Wide-field fundus photograph of an infant. Natus RetCam Envision, 130° FOV: 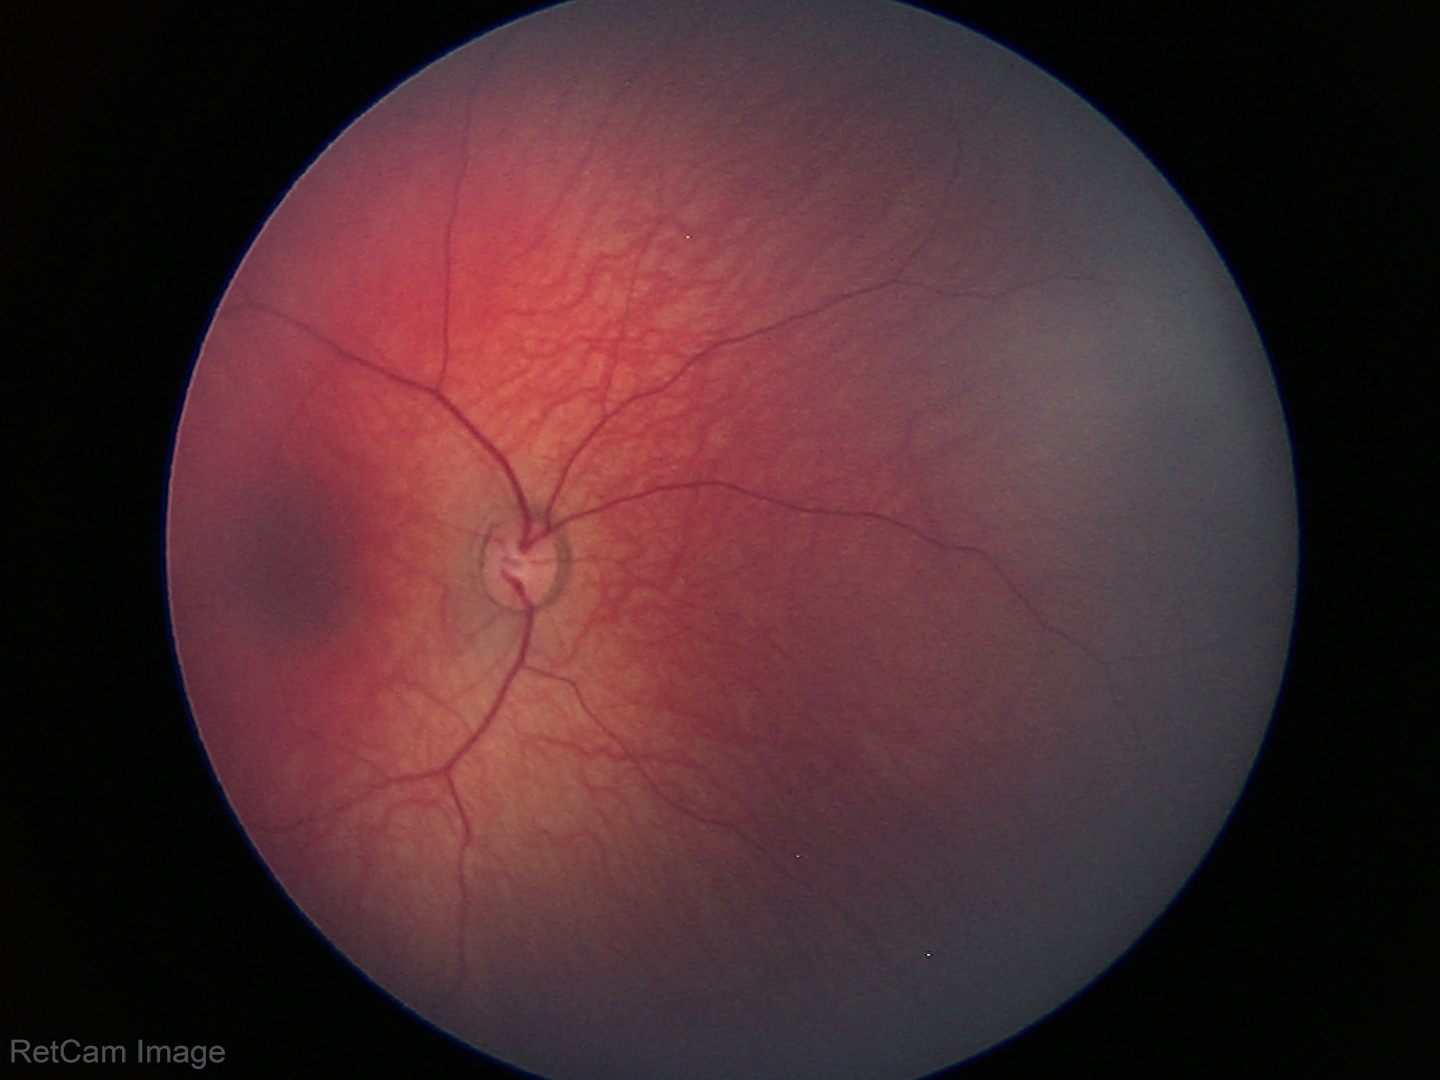
Physiological retinal appearance for postconceptual age.